Wide-field contact fundus photograph of an infant. 640x480
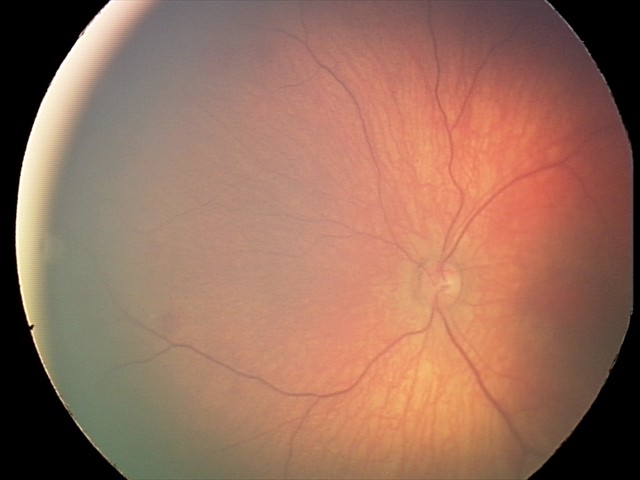
From an examination with diagnosis of retinal hemorrhages.